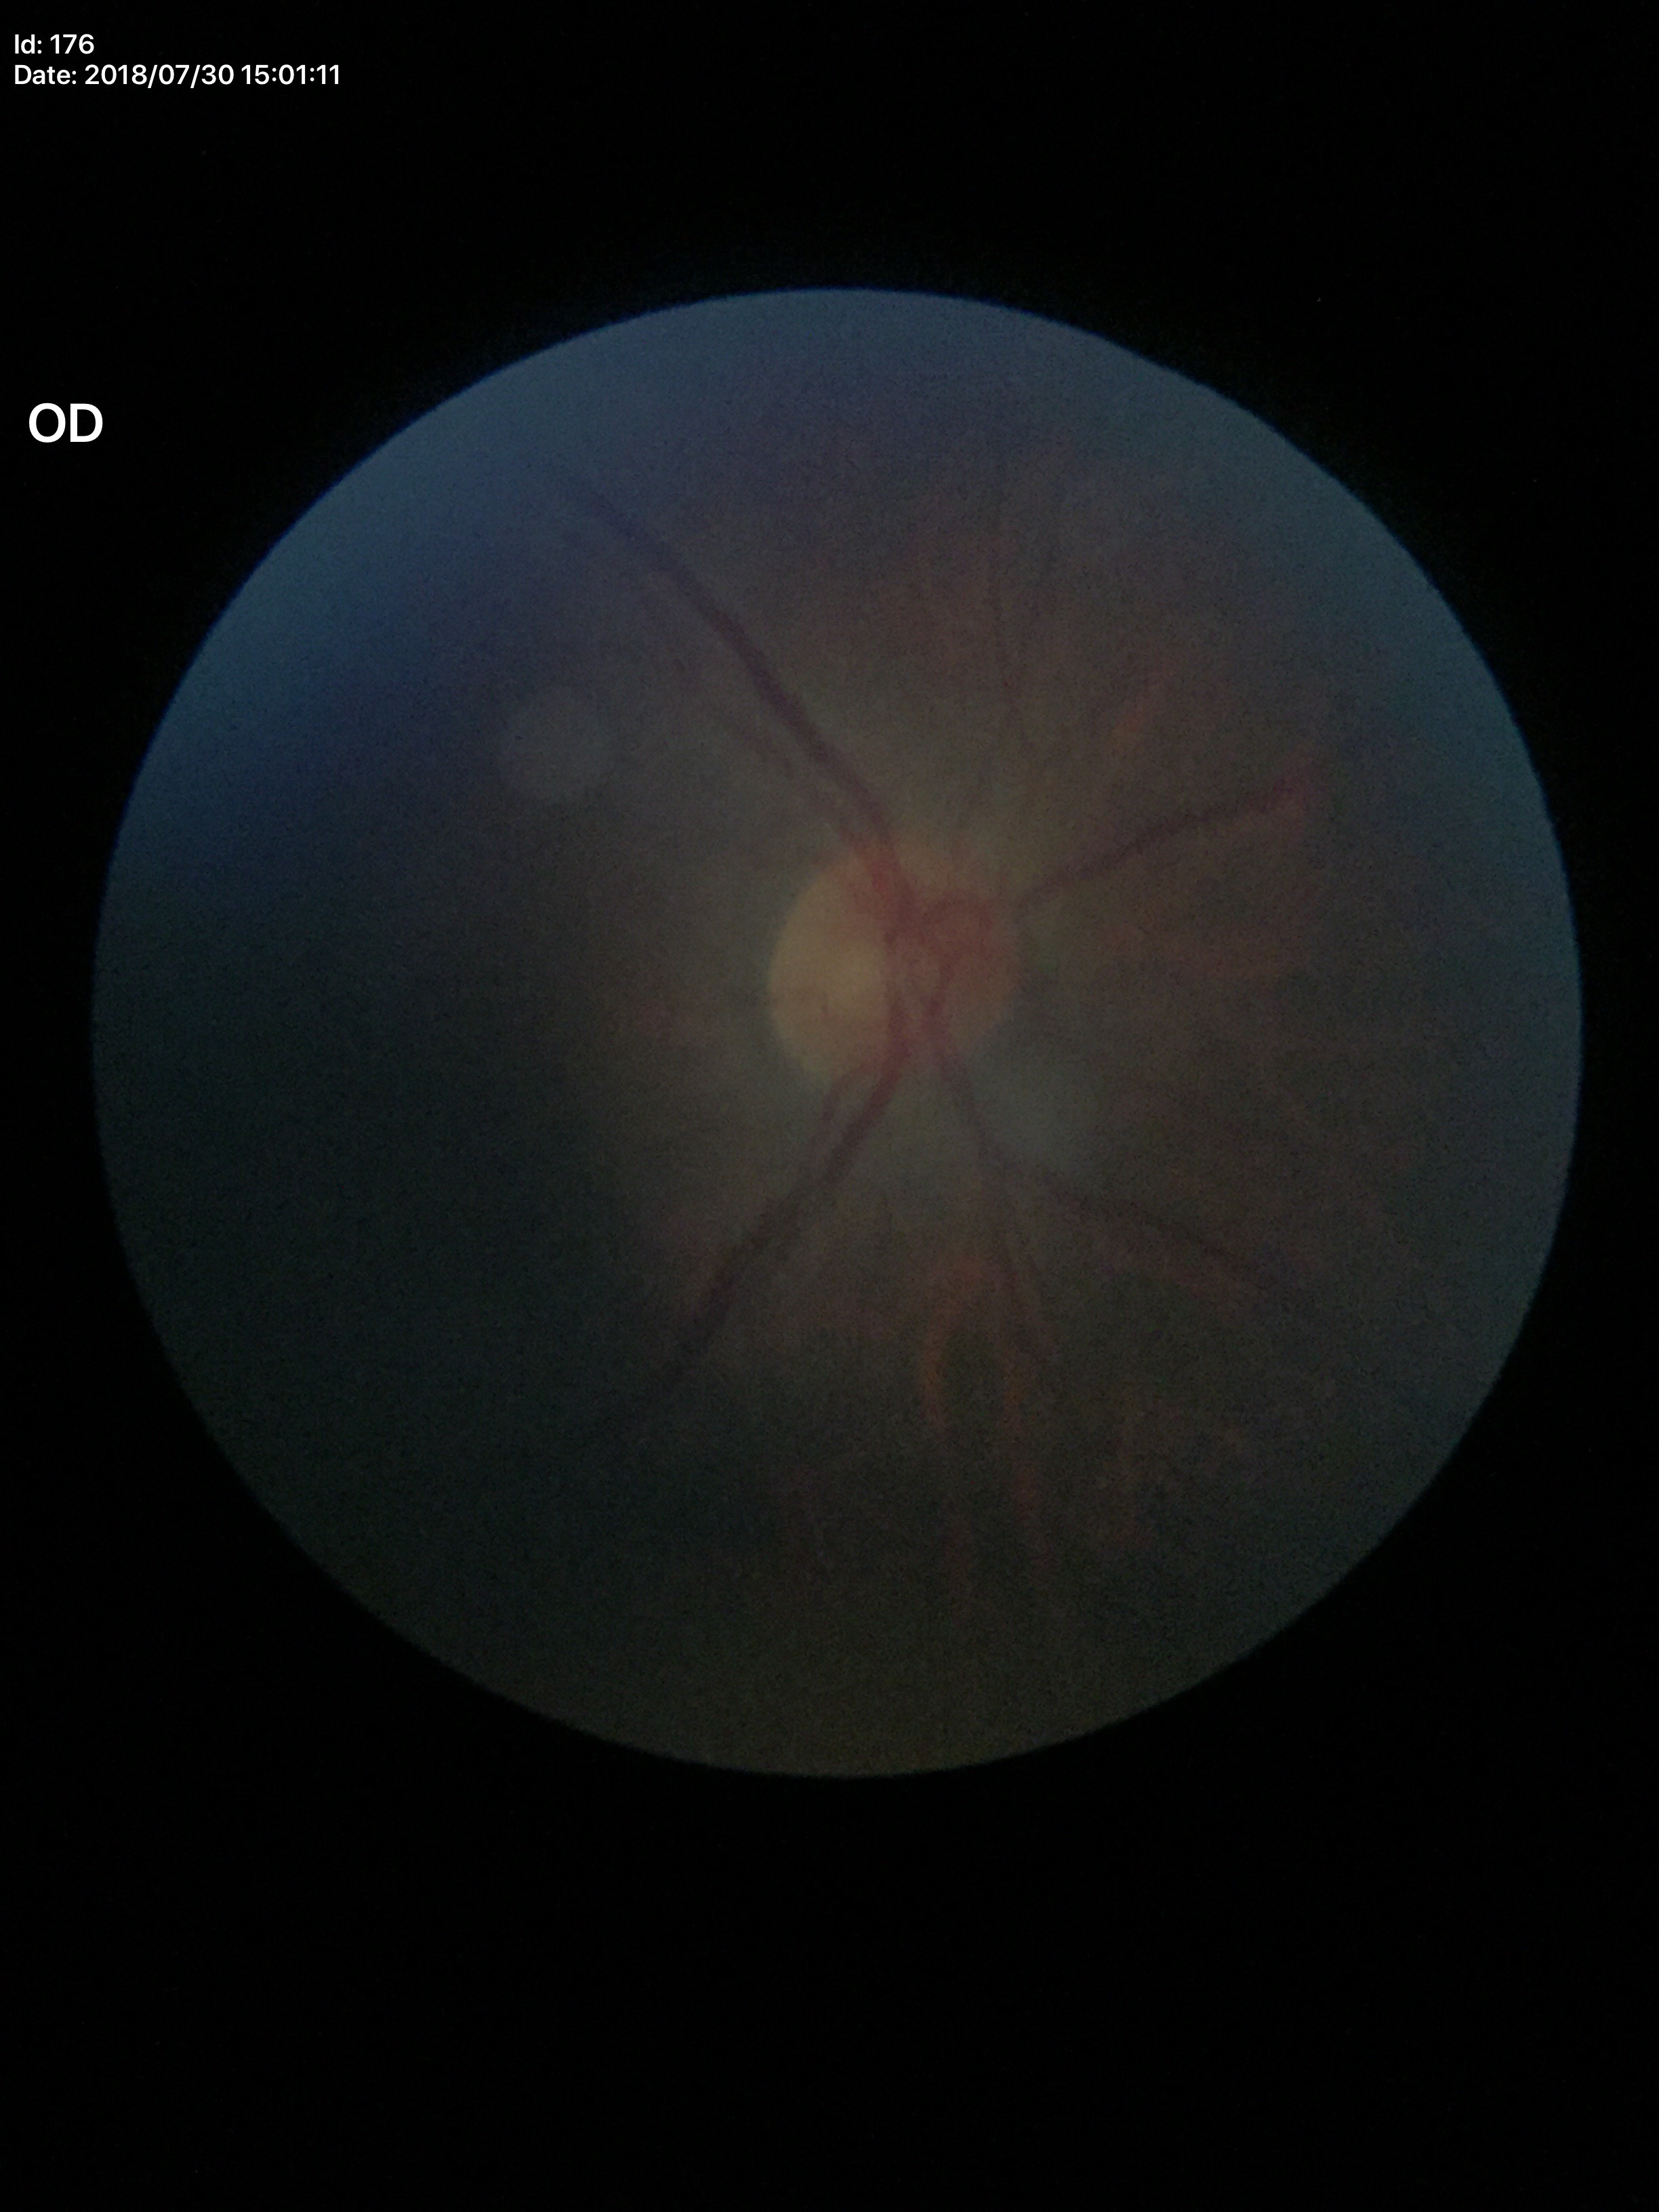 vertical CDR=0.50; horizontal cup-to-disc ratio=0.48; Glaucoma evaluation=not suspect